DR severity per modified Davis staging: 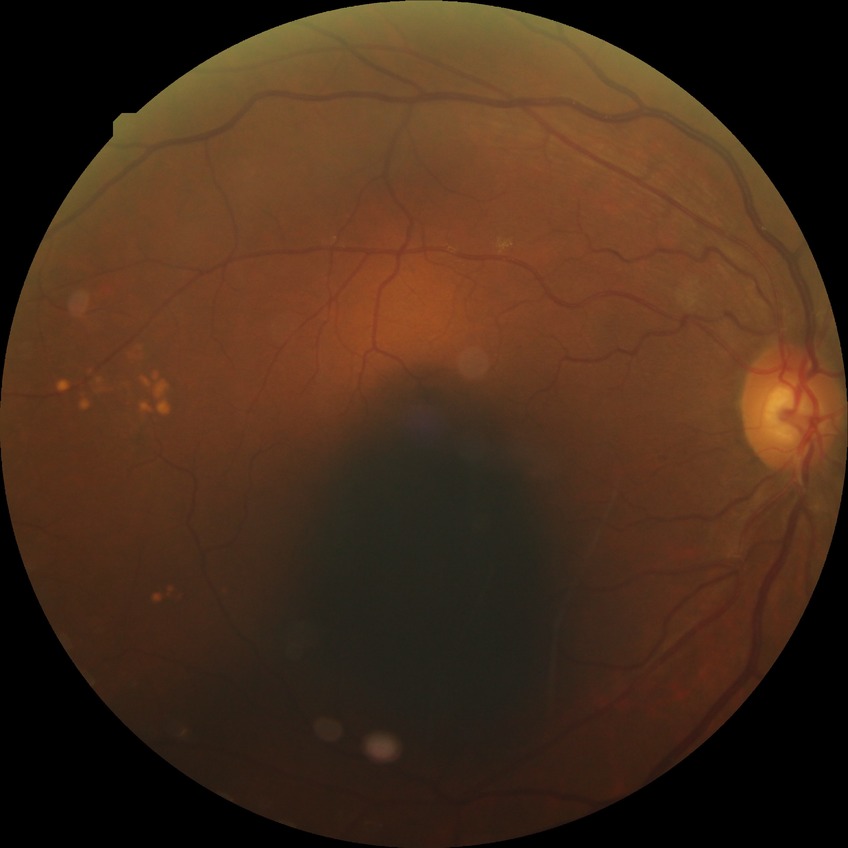

Diabetic retinopathy (DR): NDR (no diabetic retinopathy).